Acquired with a NIDEK AFC-230
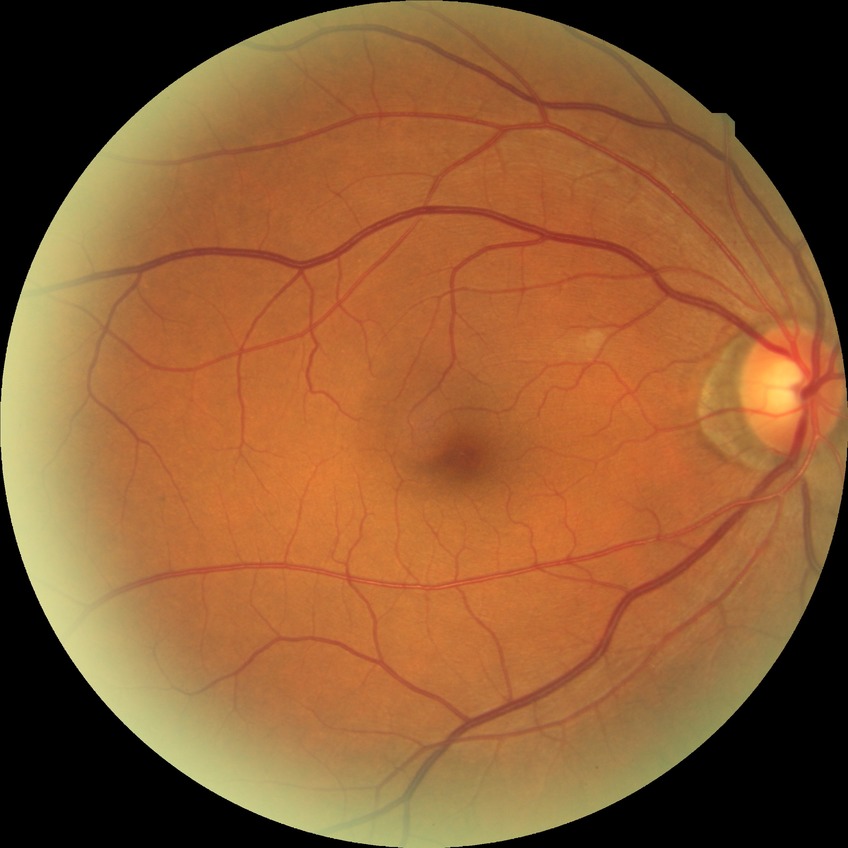

Diabetic retinopathy (DR): NDR (no diabetic retinopathy).